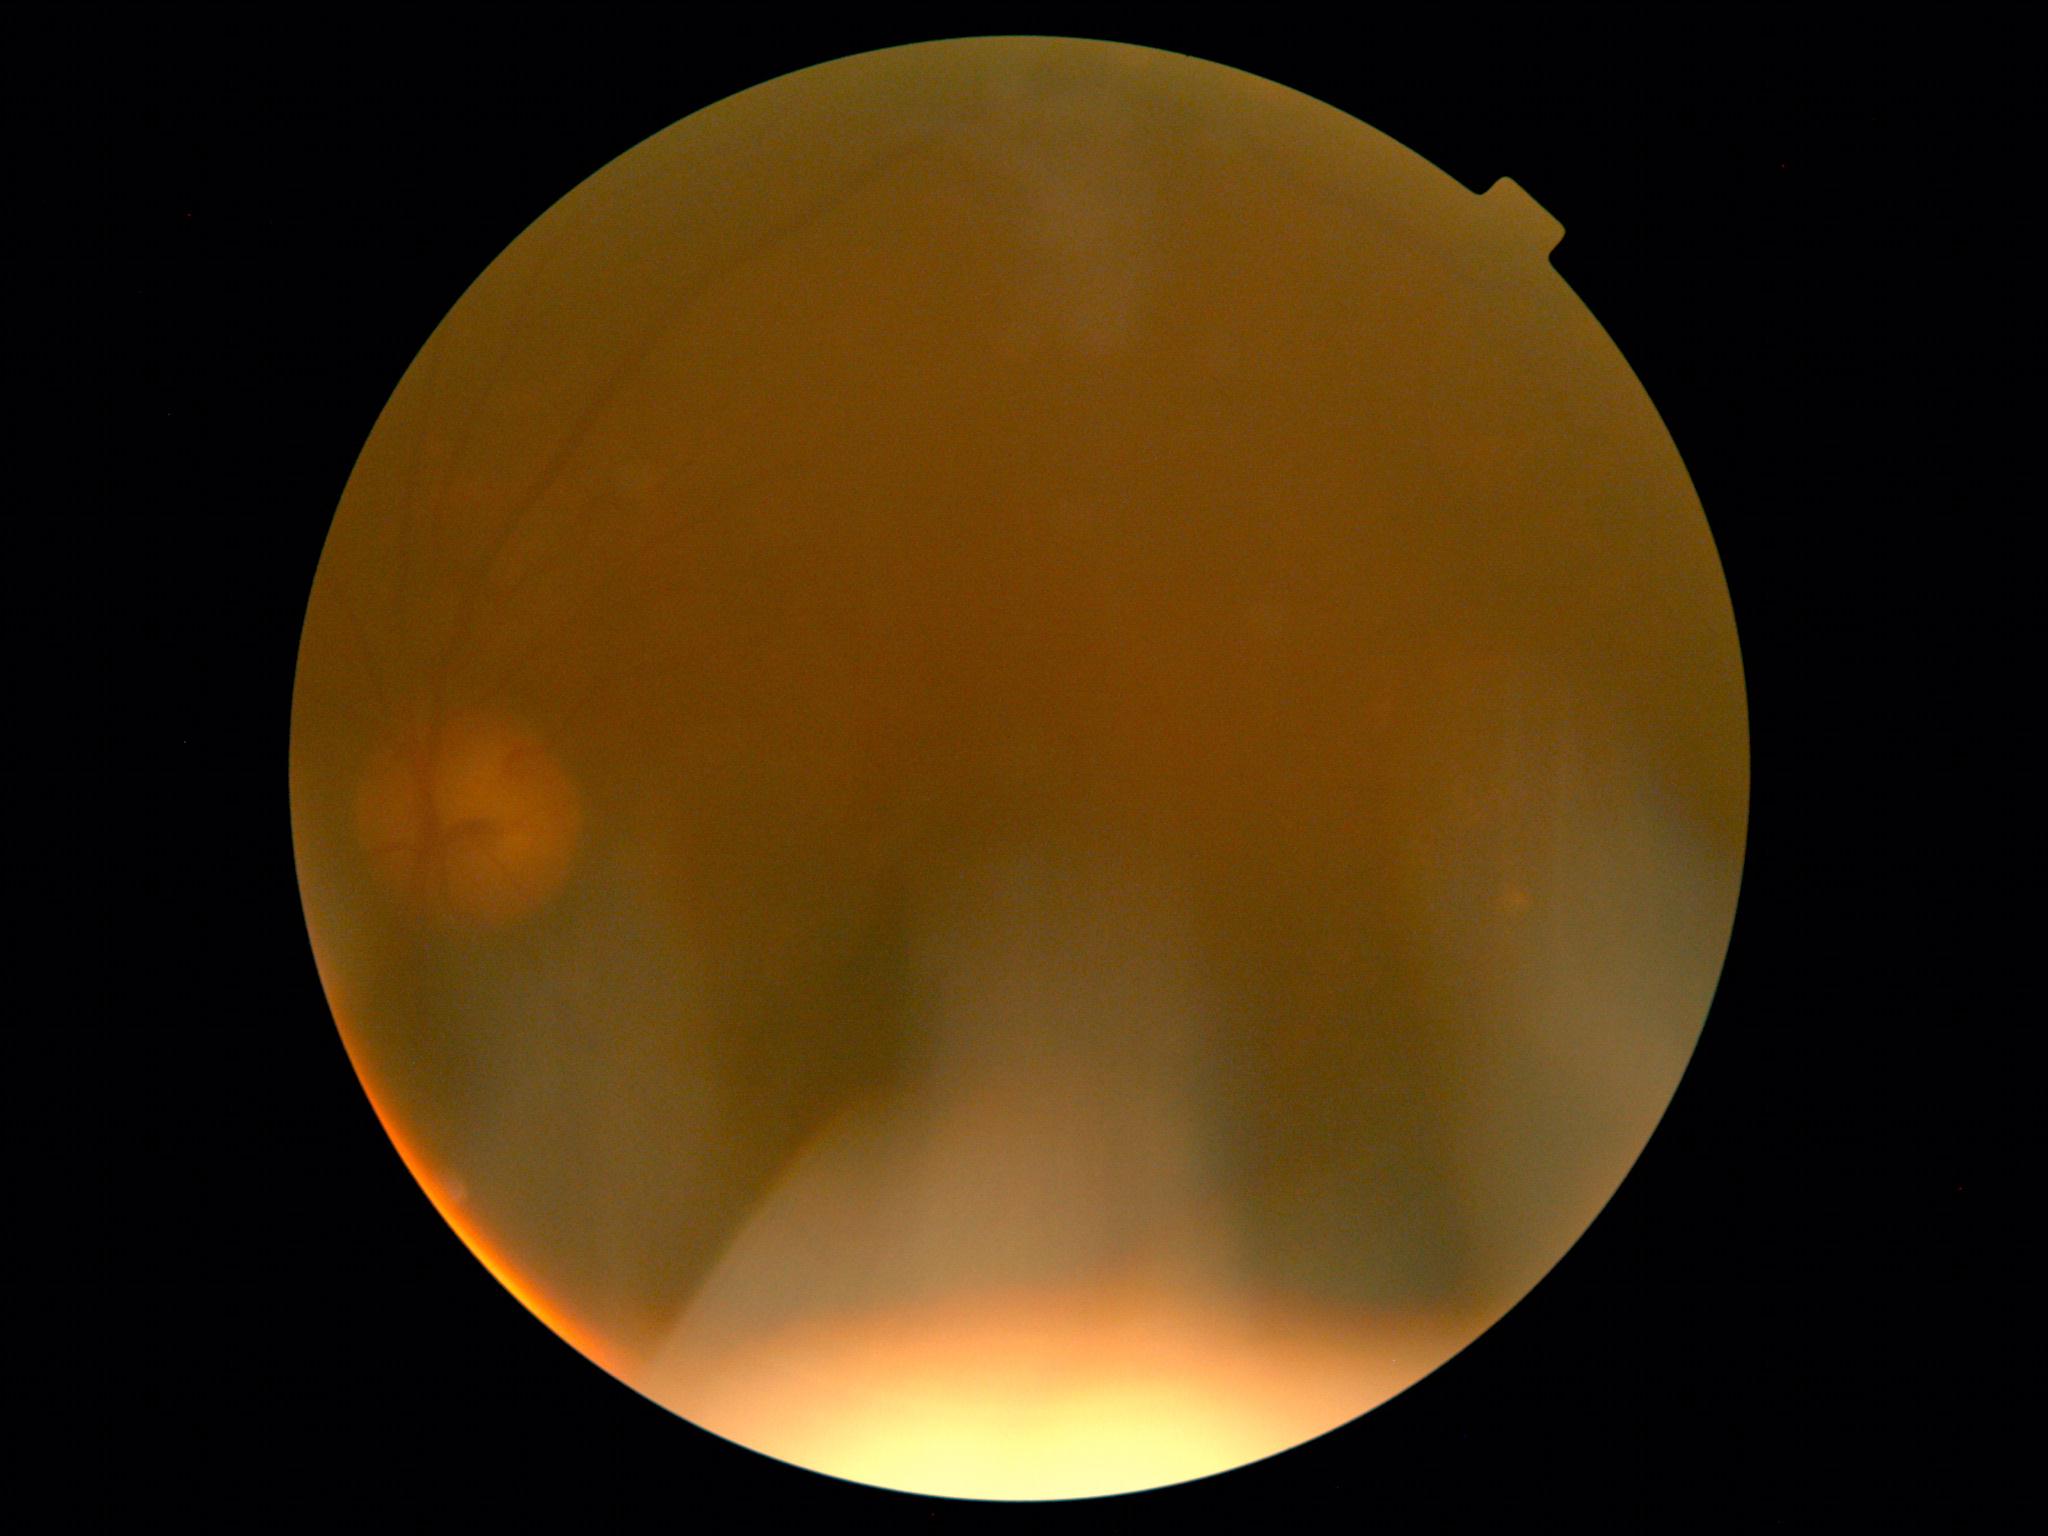

Diabetic retinopathy grade is ungradable.
Quality too poor to assess for DR.